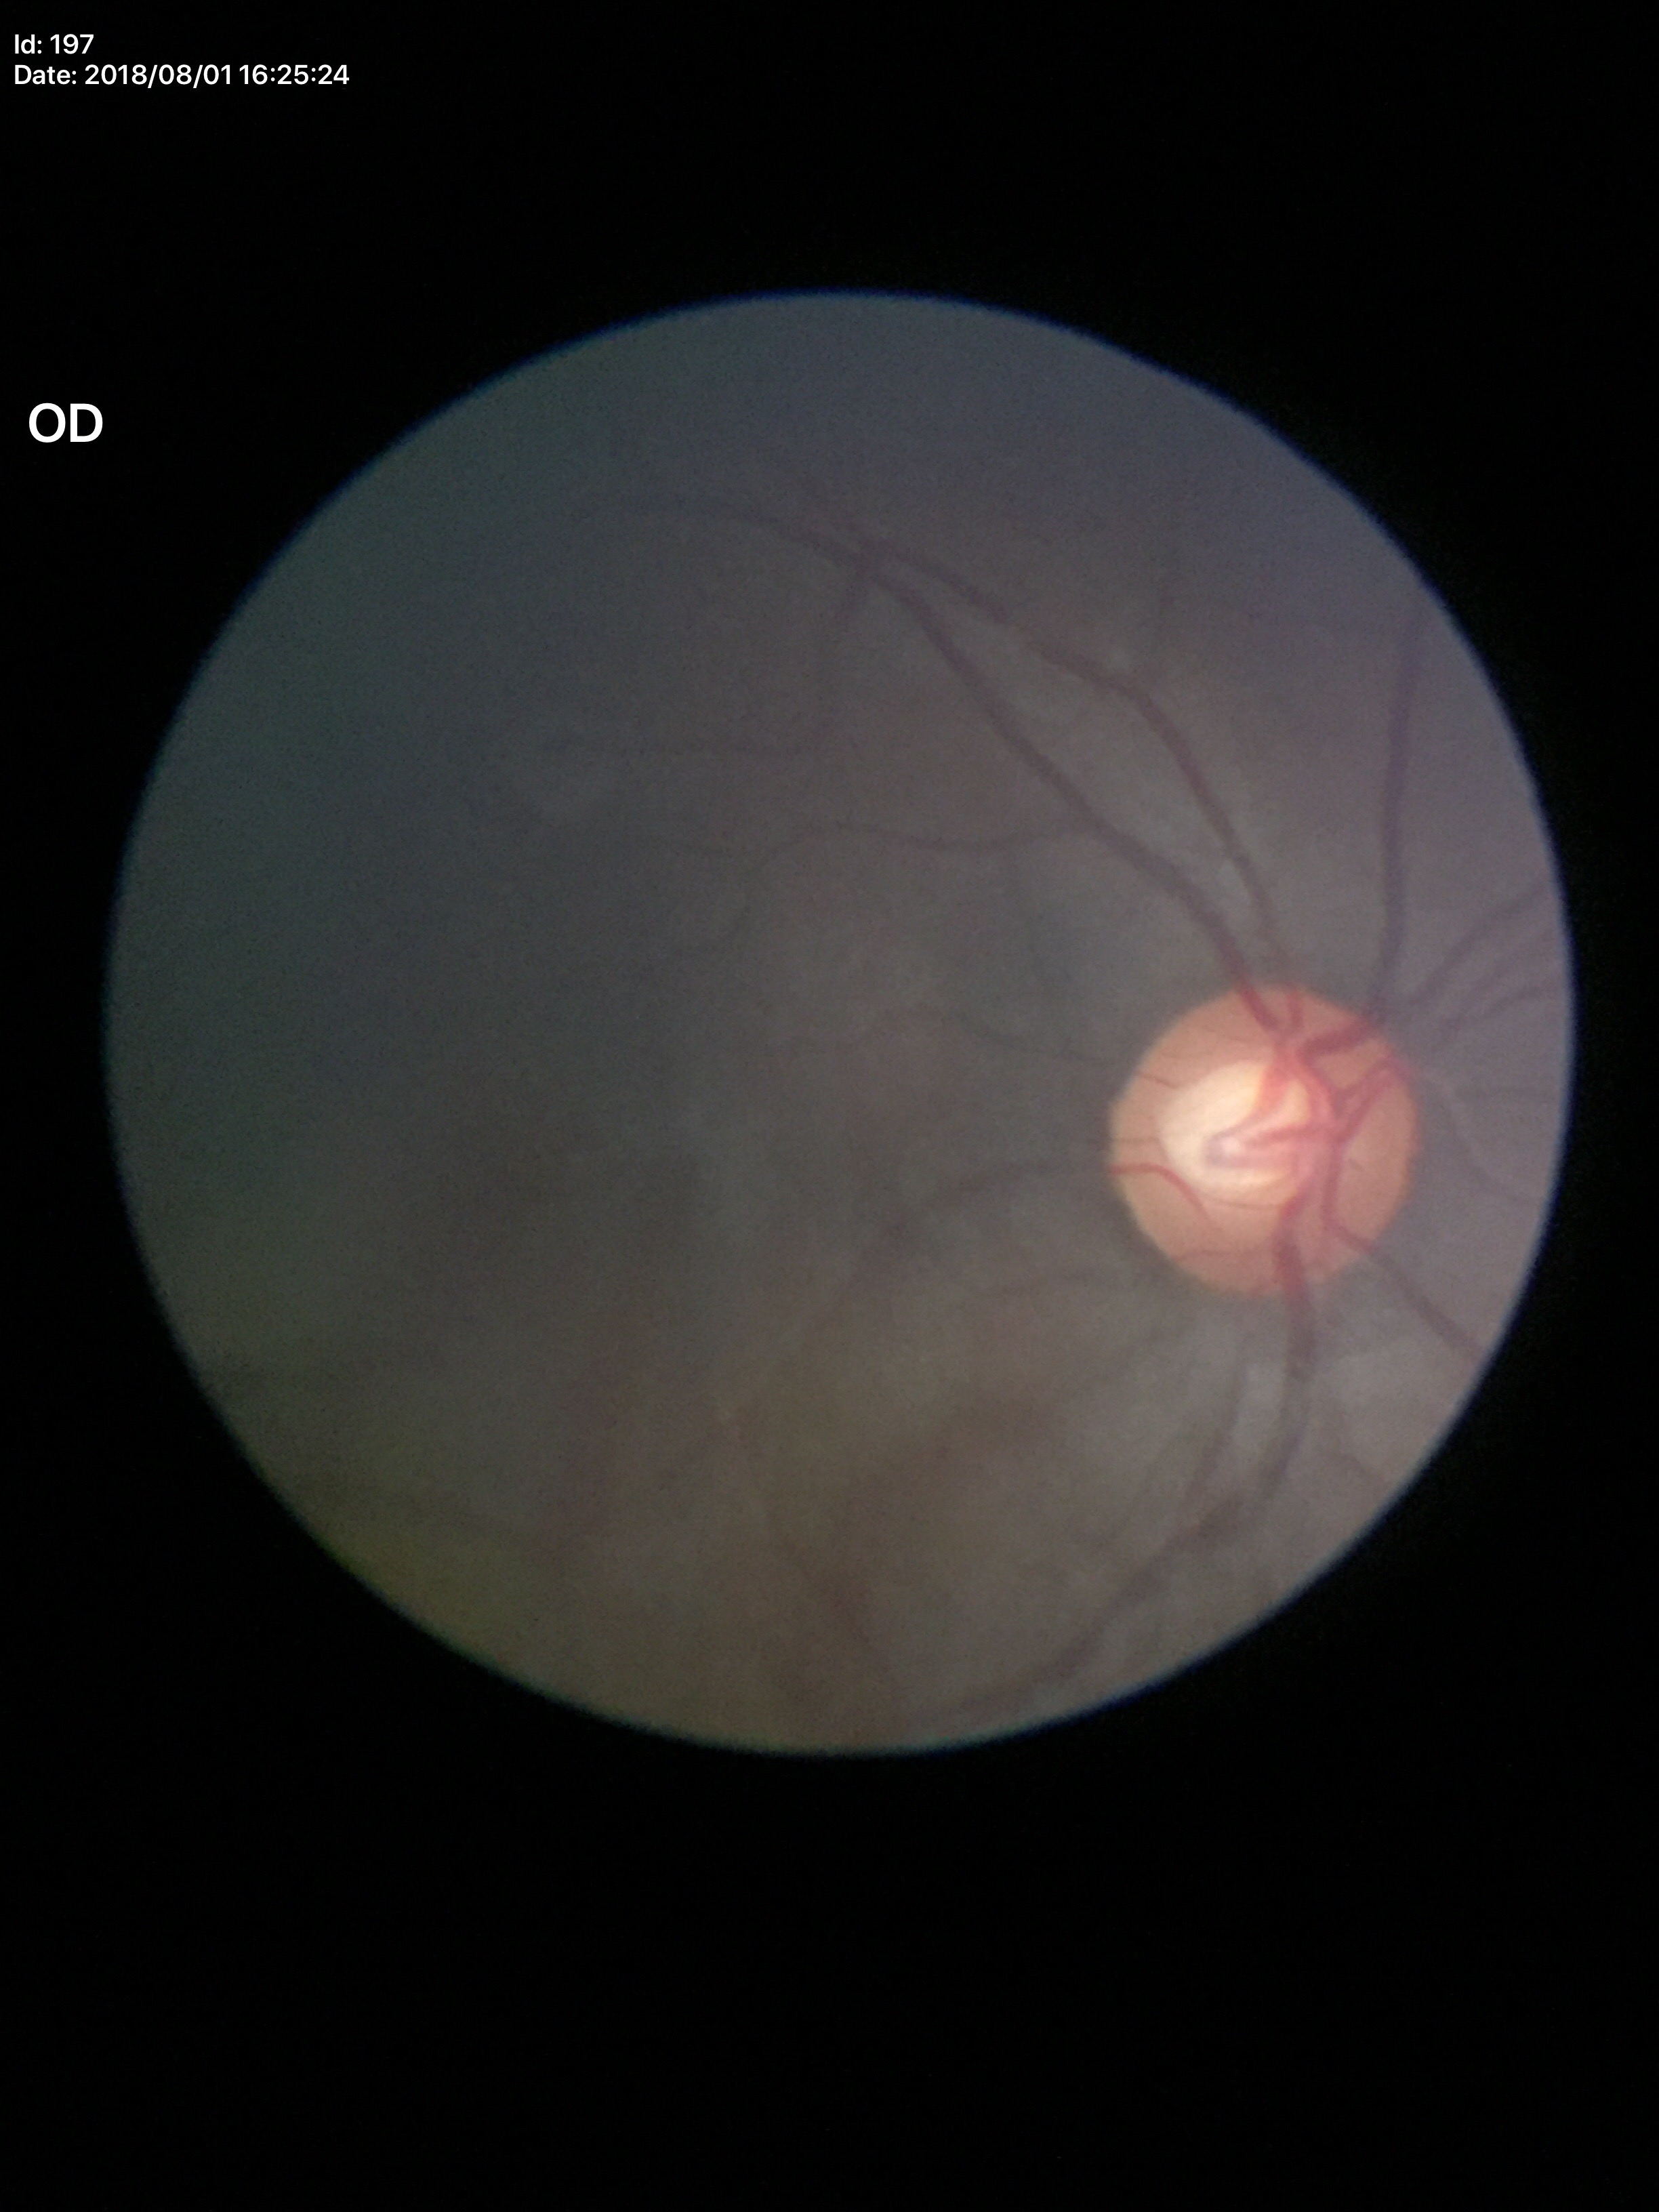
Suspect for glaucomatous optic neuropathy. Vertical CDR is 0.60.